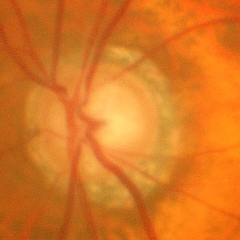

Fundus image with findings of early glaucomatous changes.